Color fundus photograph.
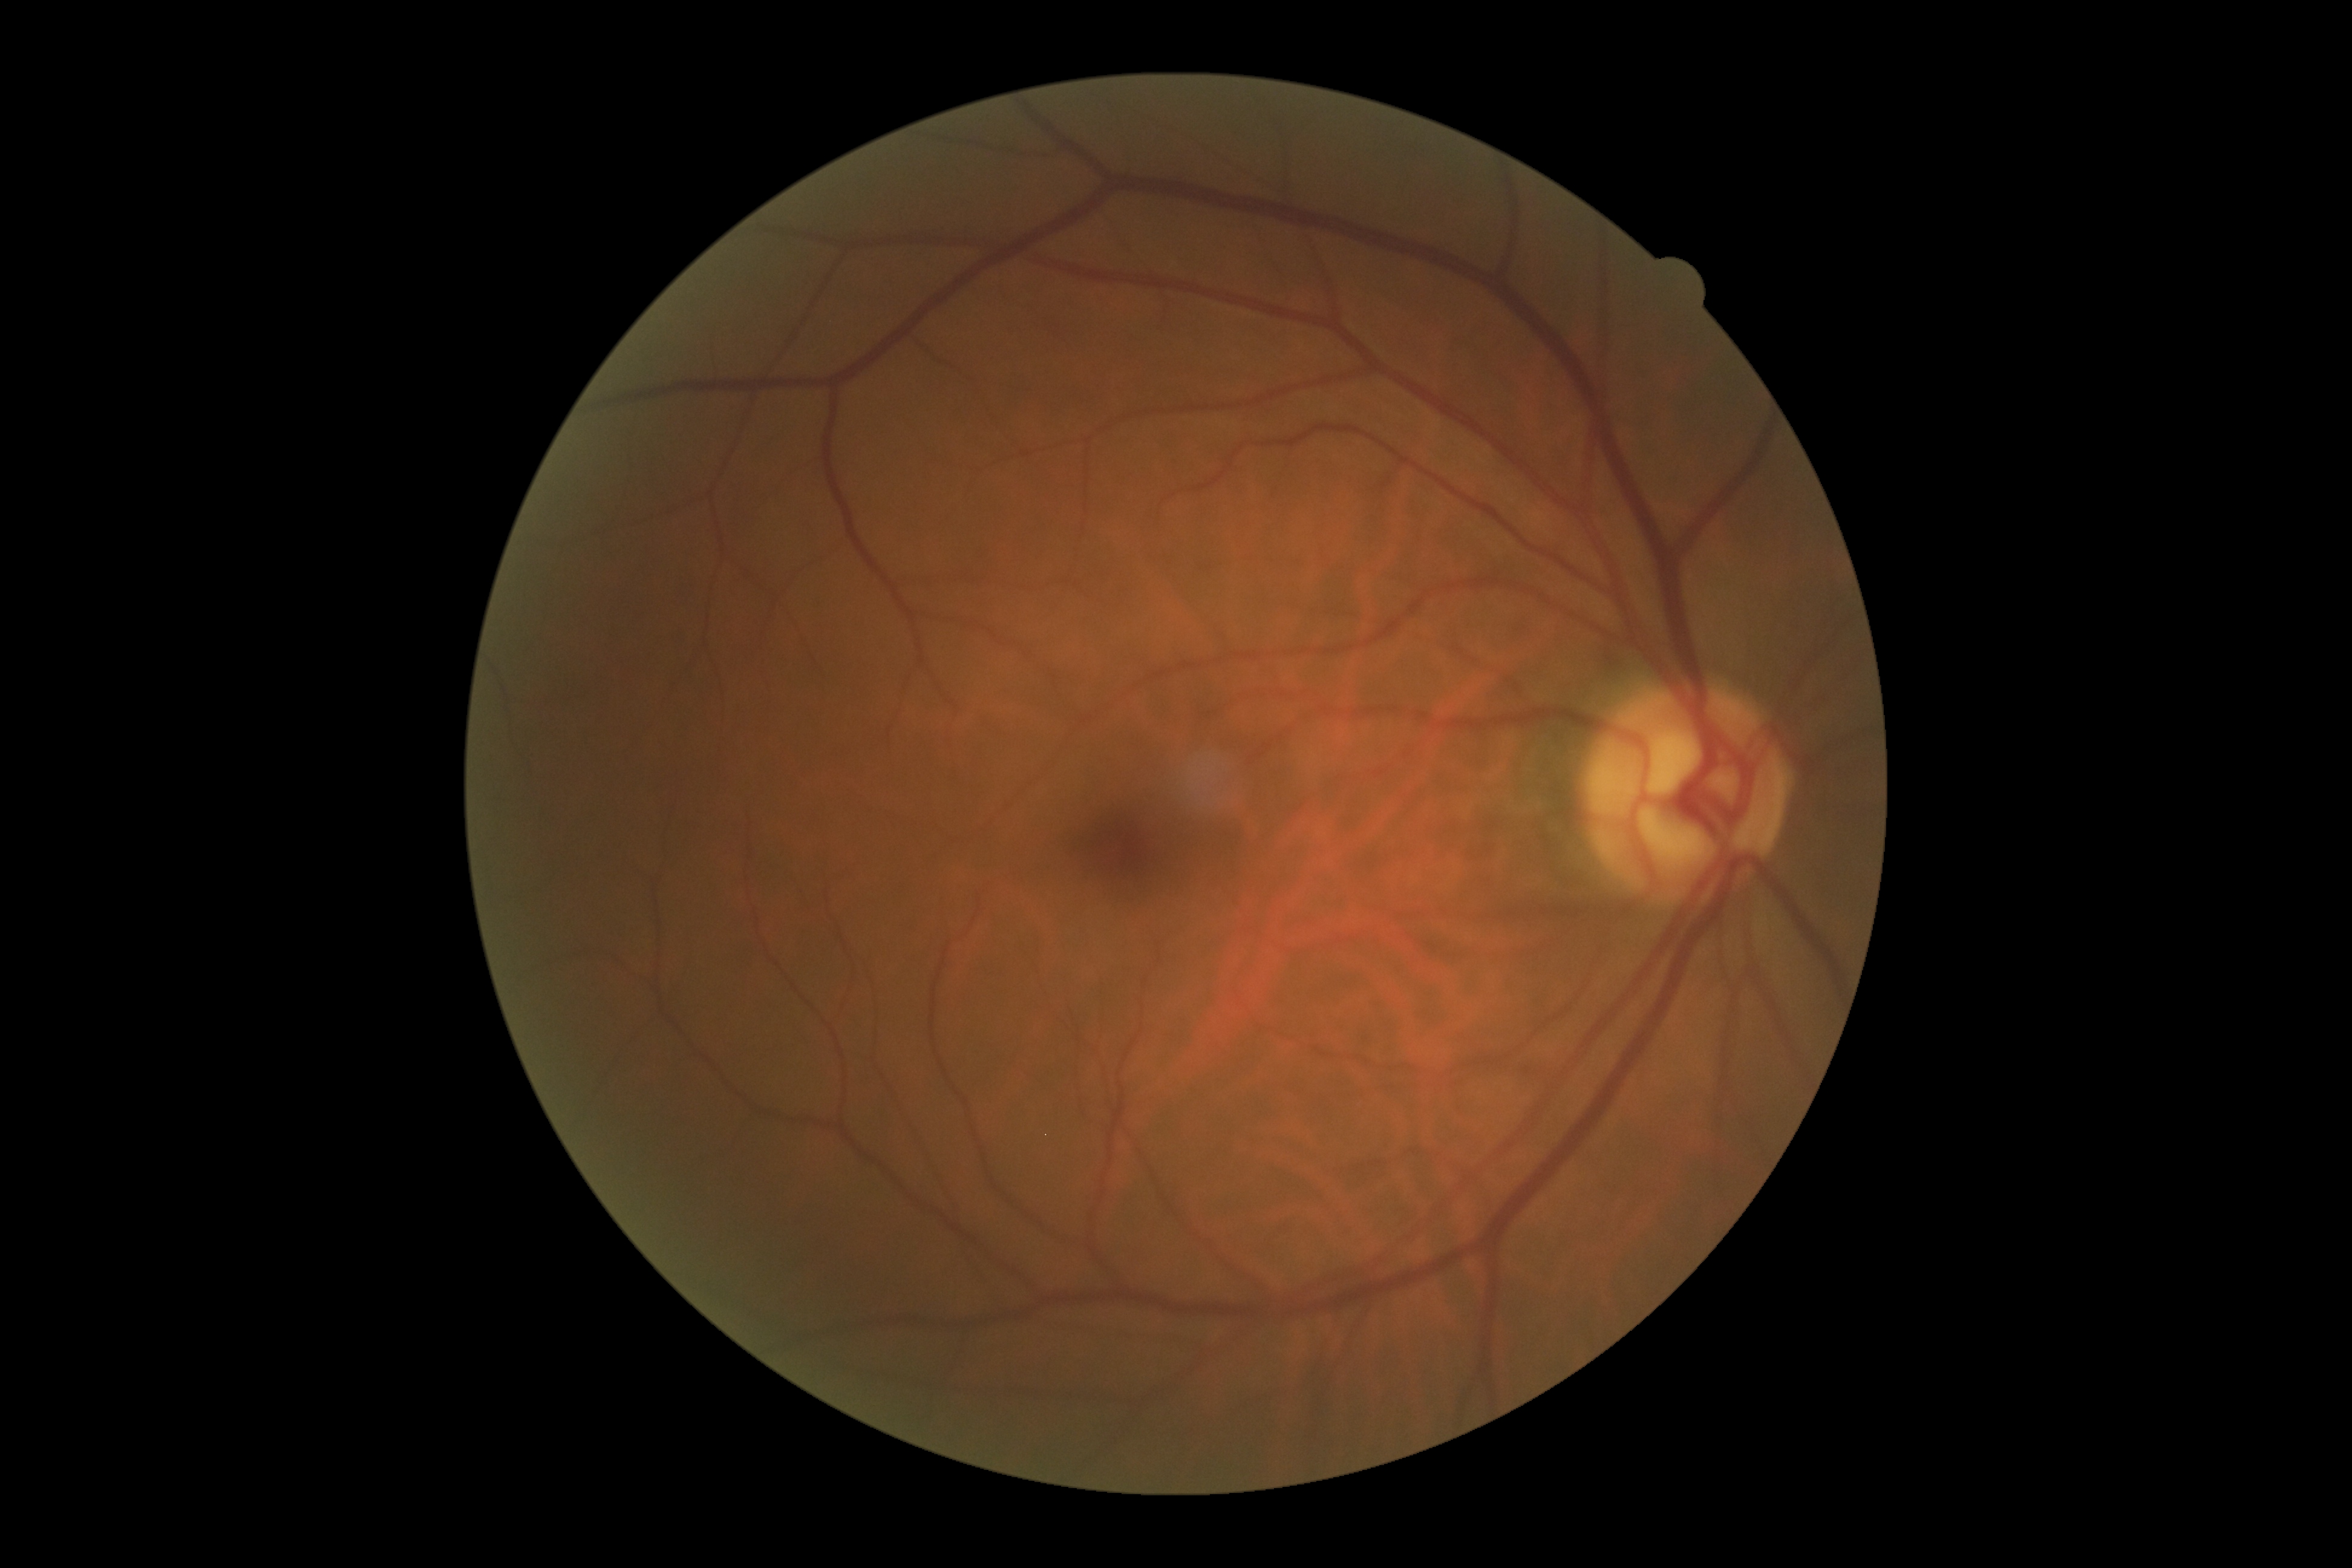
diabetic retinopathy (DR) = grade 0